Pediatric retinal photograph (wide-field) · captured with the Clarity RetCam 3 (130° field of view)
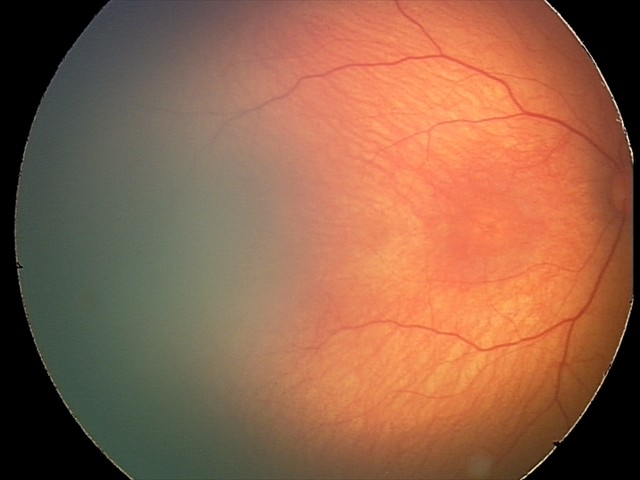 Screening examination with no abnormal retinal findings.